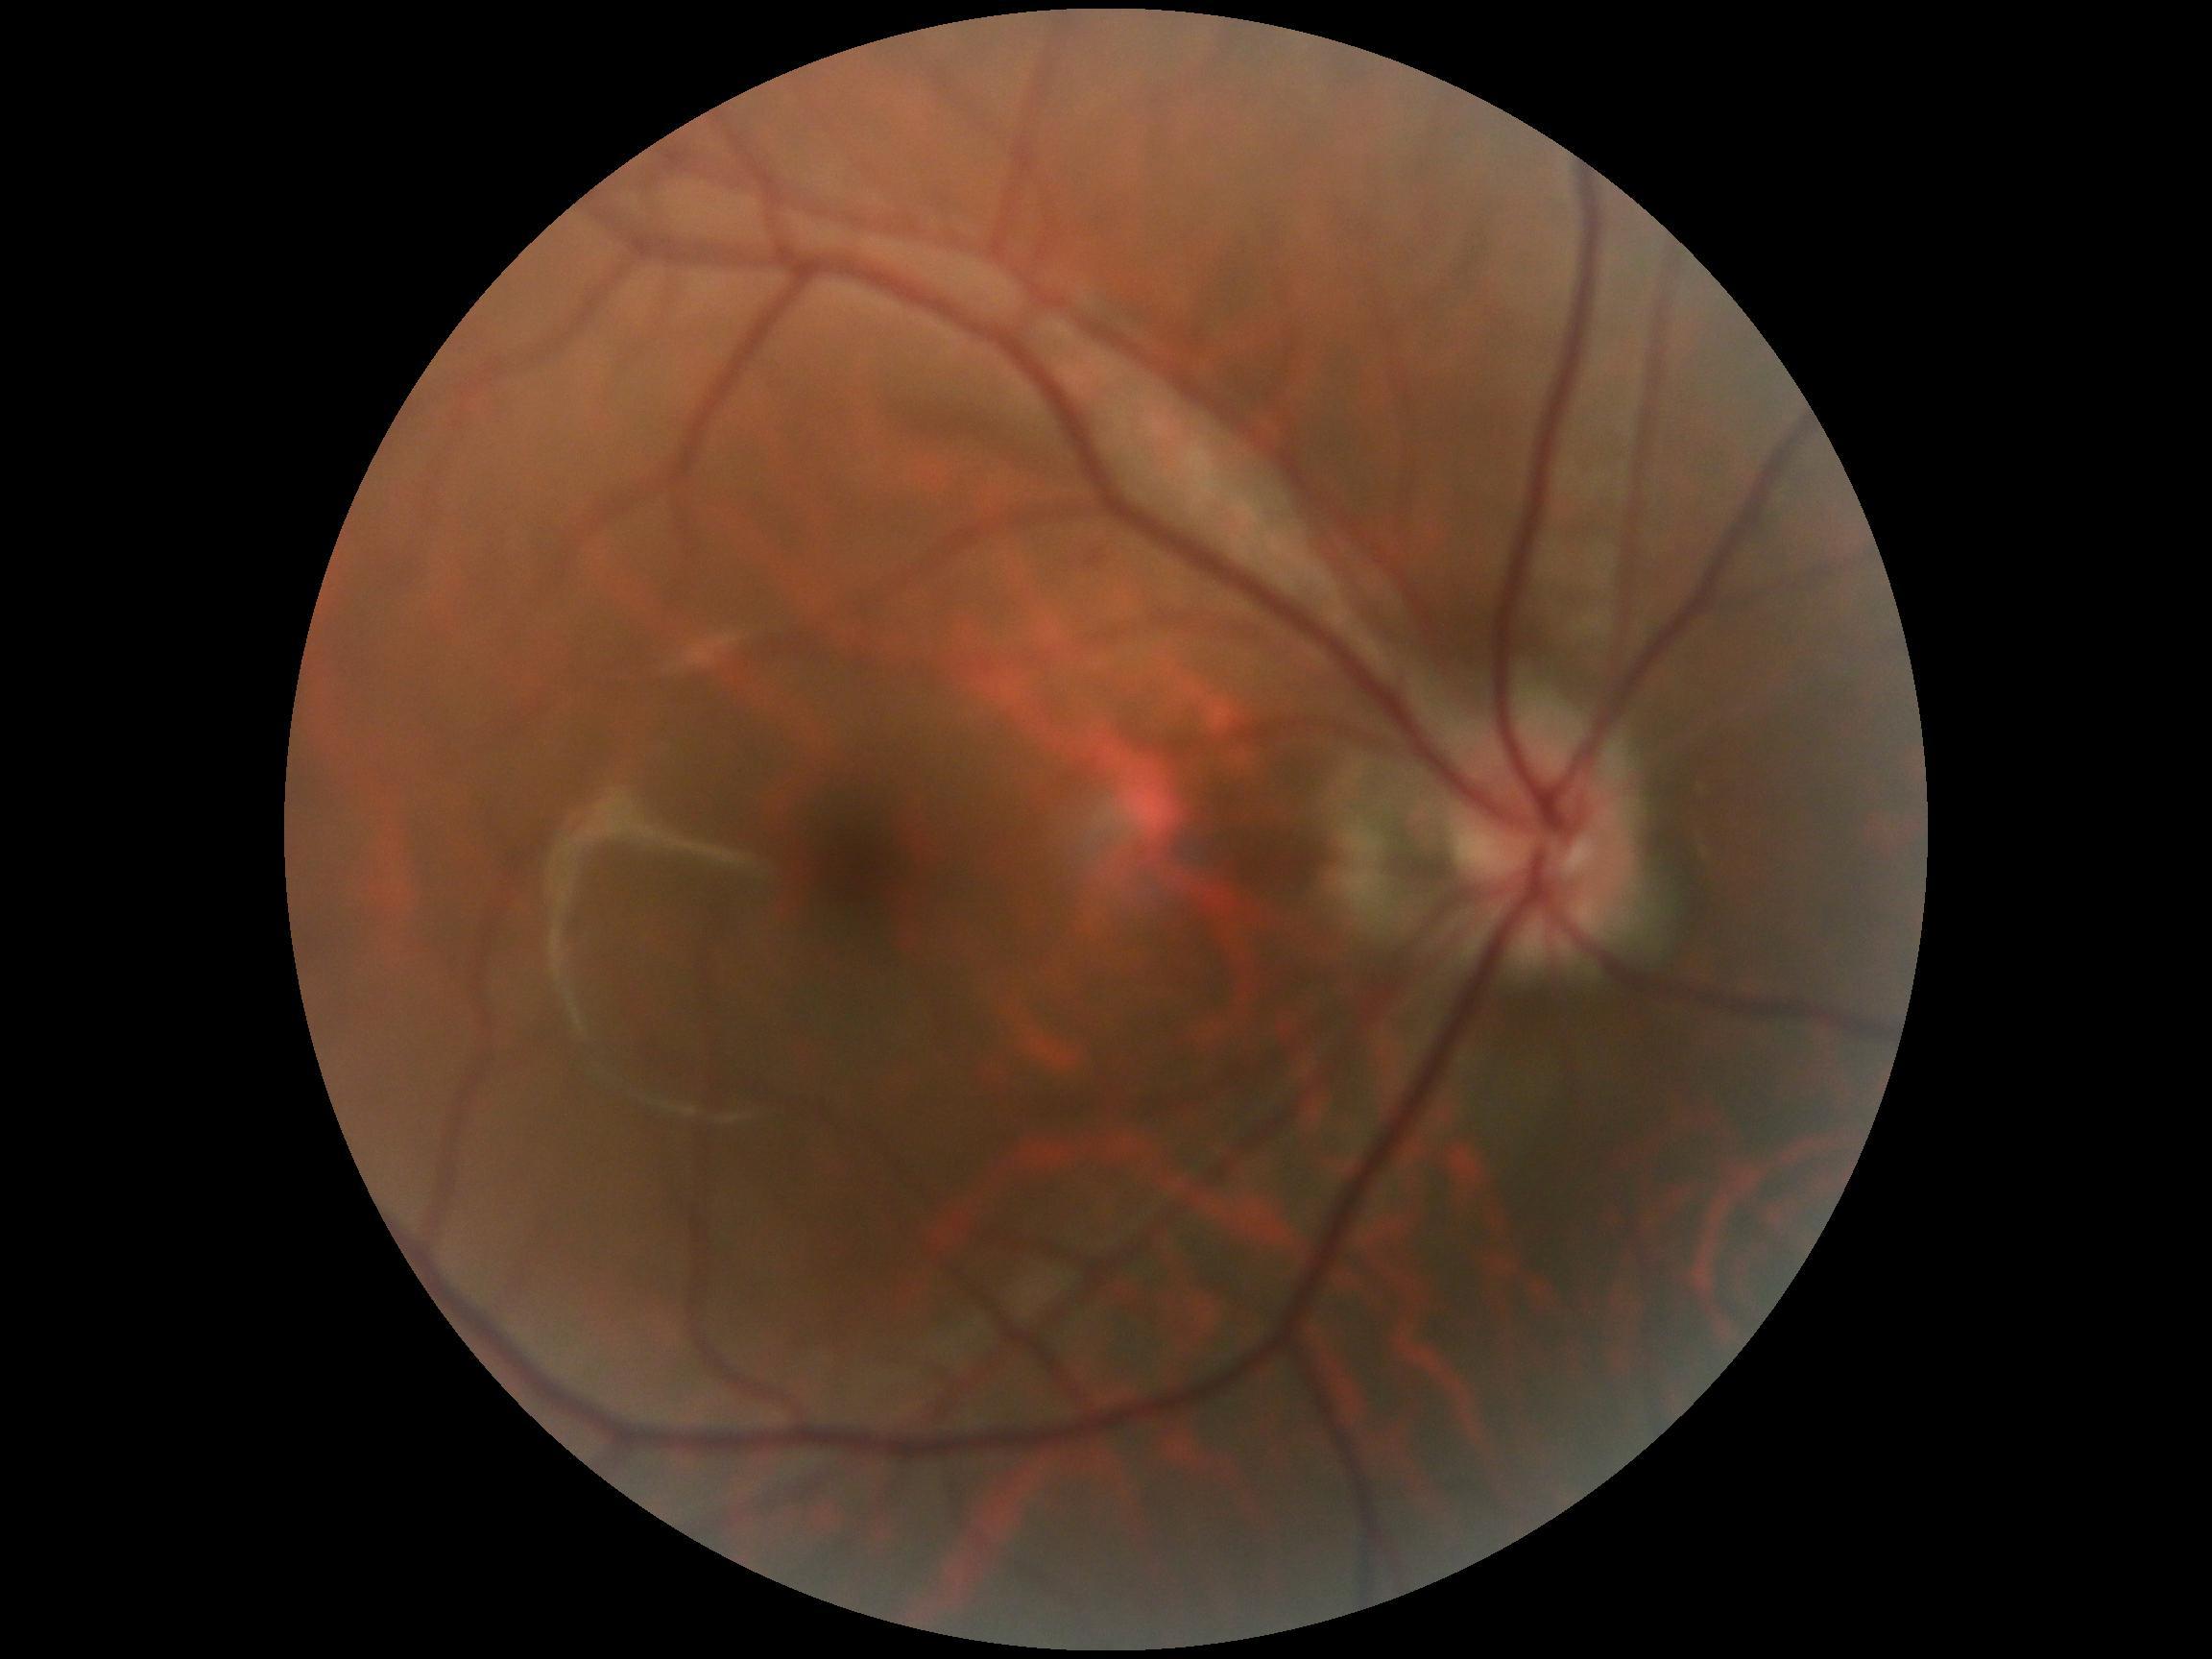

{"dr_grade": "0/4"}